1659x2212px · captured on a Remidio Fundus on Phone:
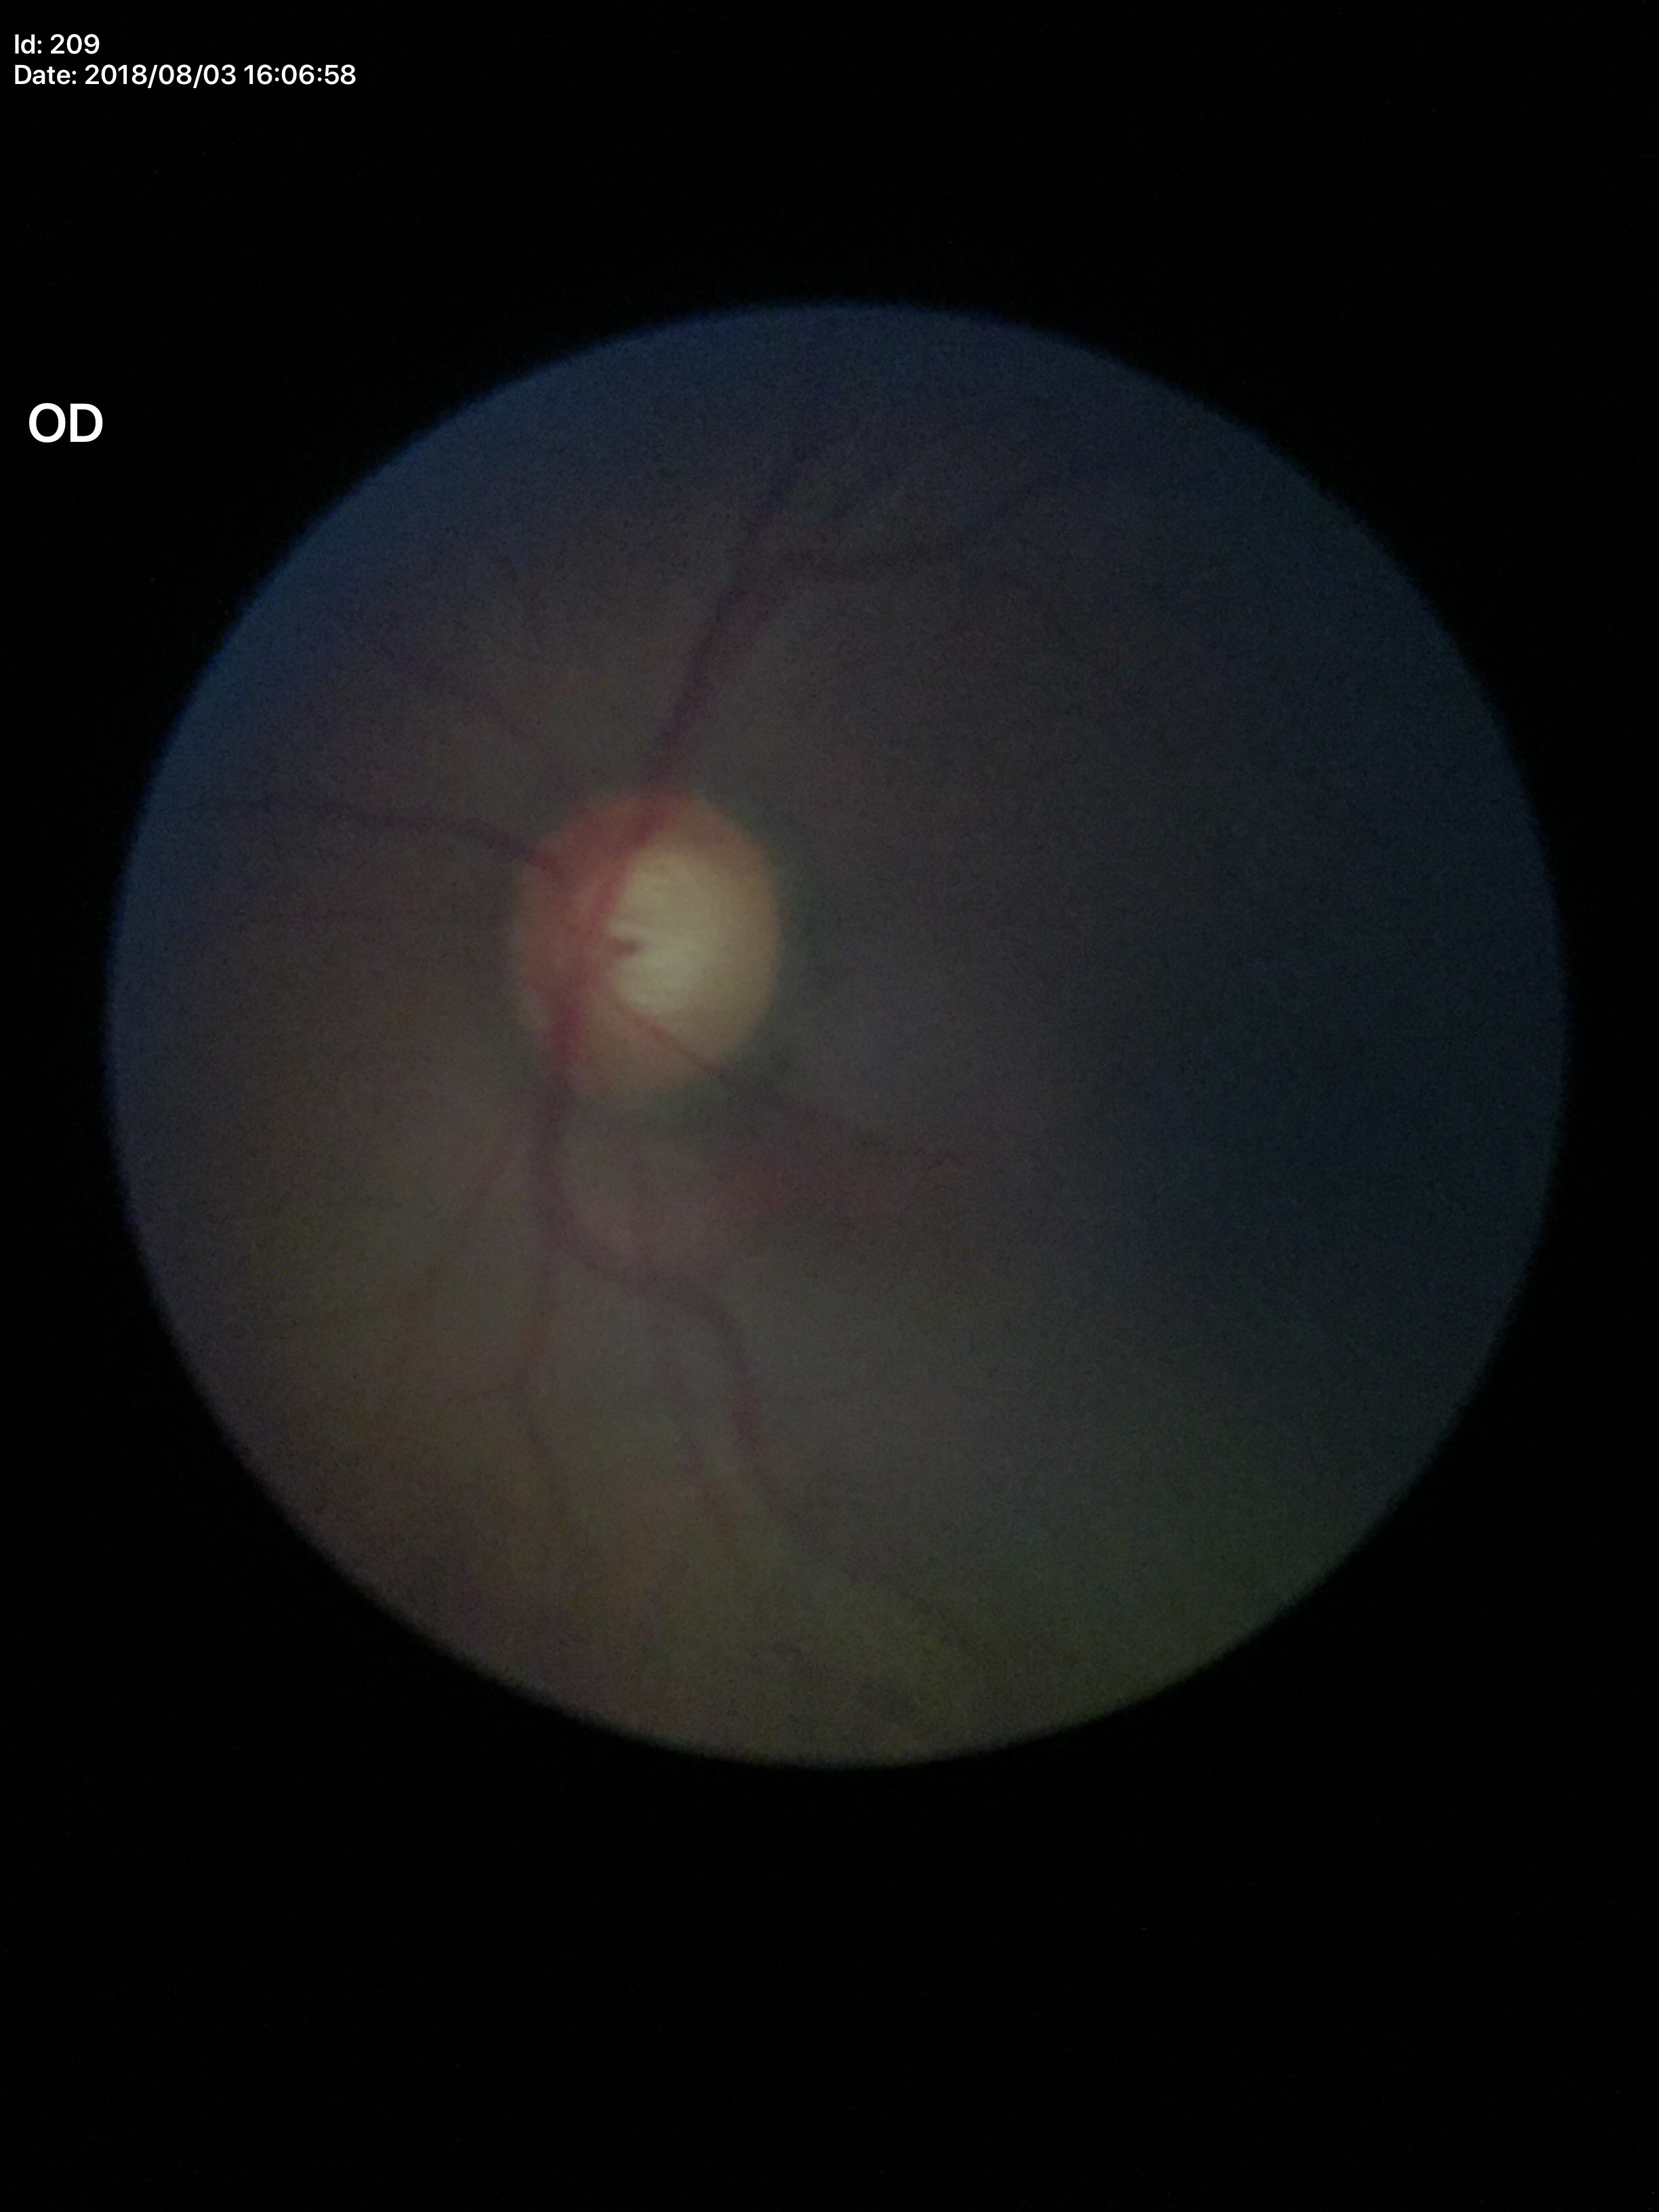
Glaucoma-suspect optic disc appearance (4/5 graders called glaucoma suspect).
VCDR: 0.65.
HCDR is 0.61.